Non-mydriatic acquisition:
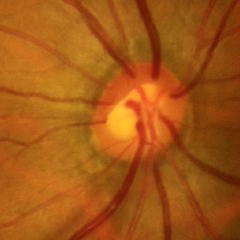
This fundus photograph shows early glaucomatous optic neuropathy.